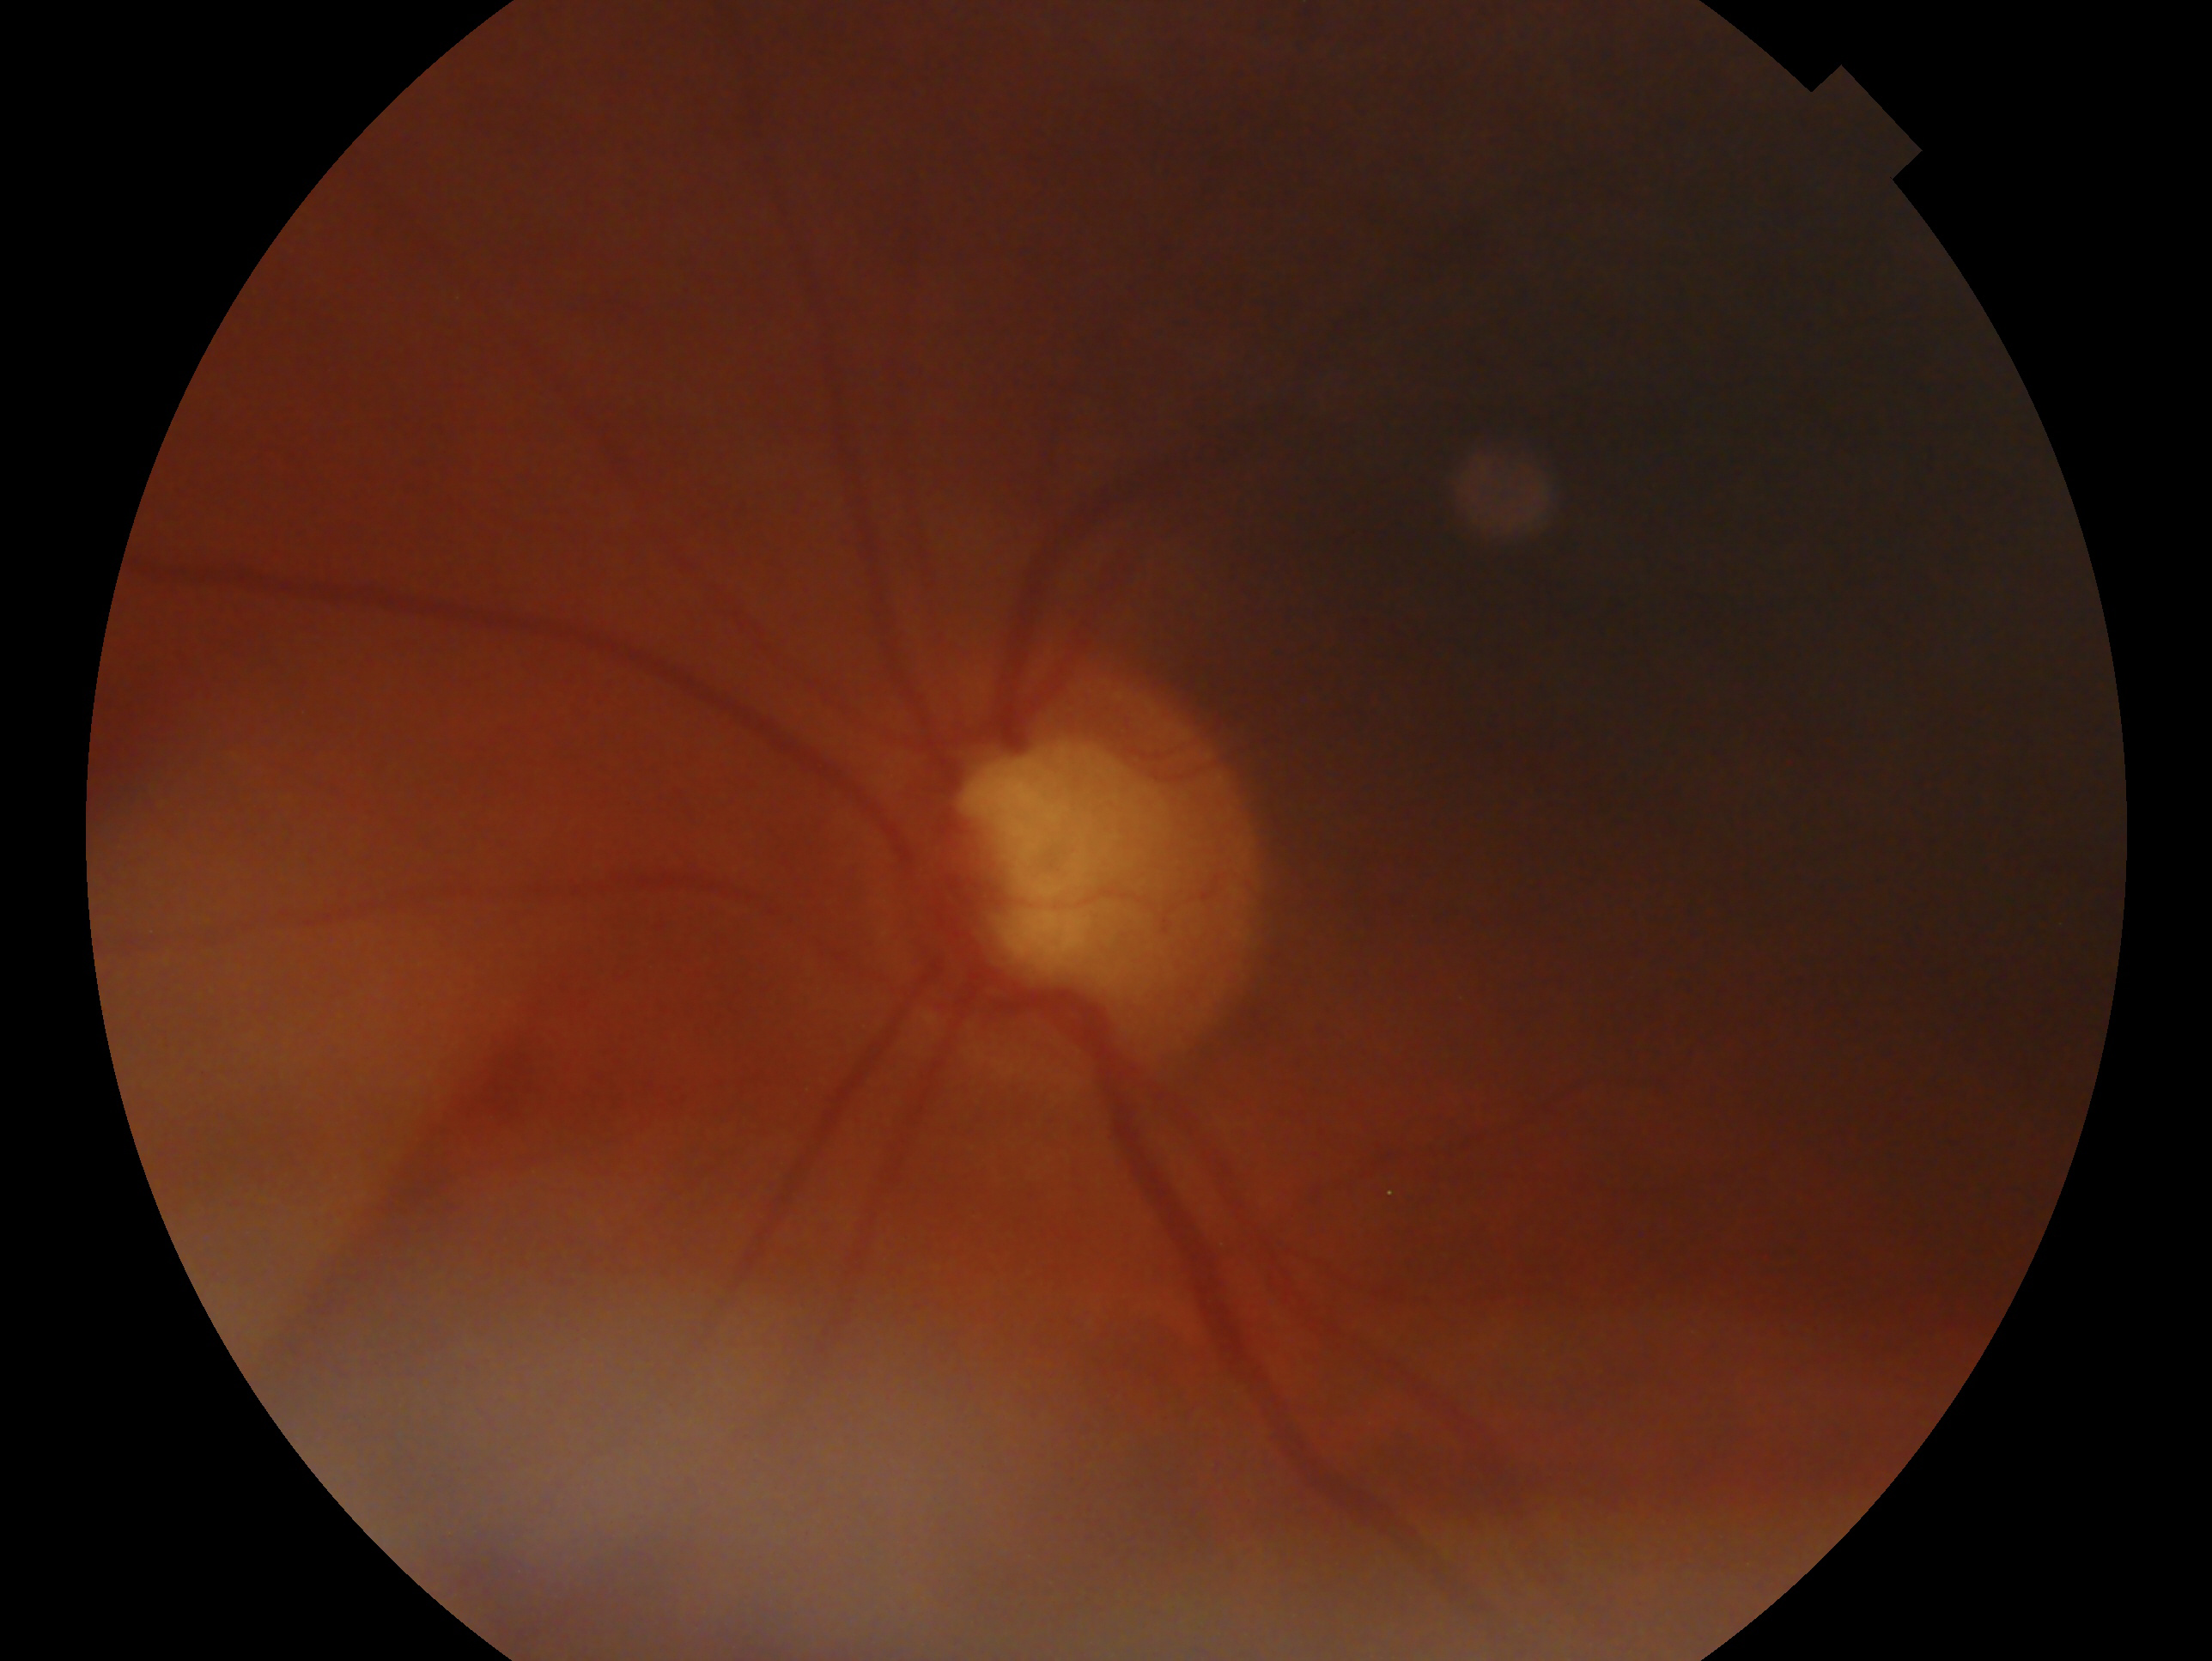 {
  "glaucoma_dx": "glaucoma",
  "eye": "OS"
}